45-degree field of view
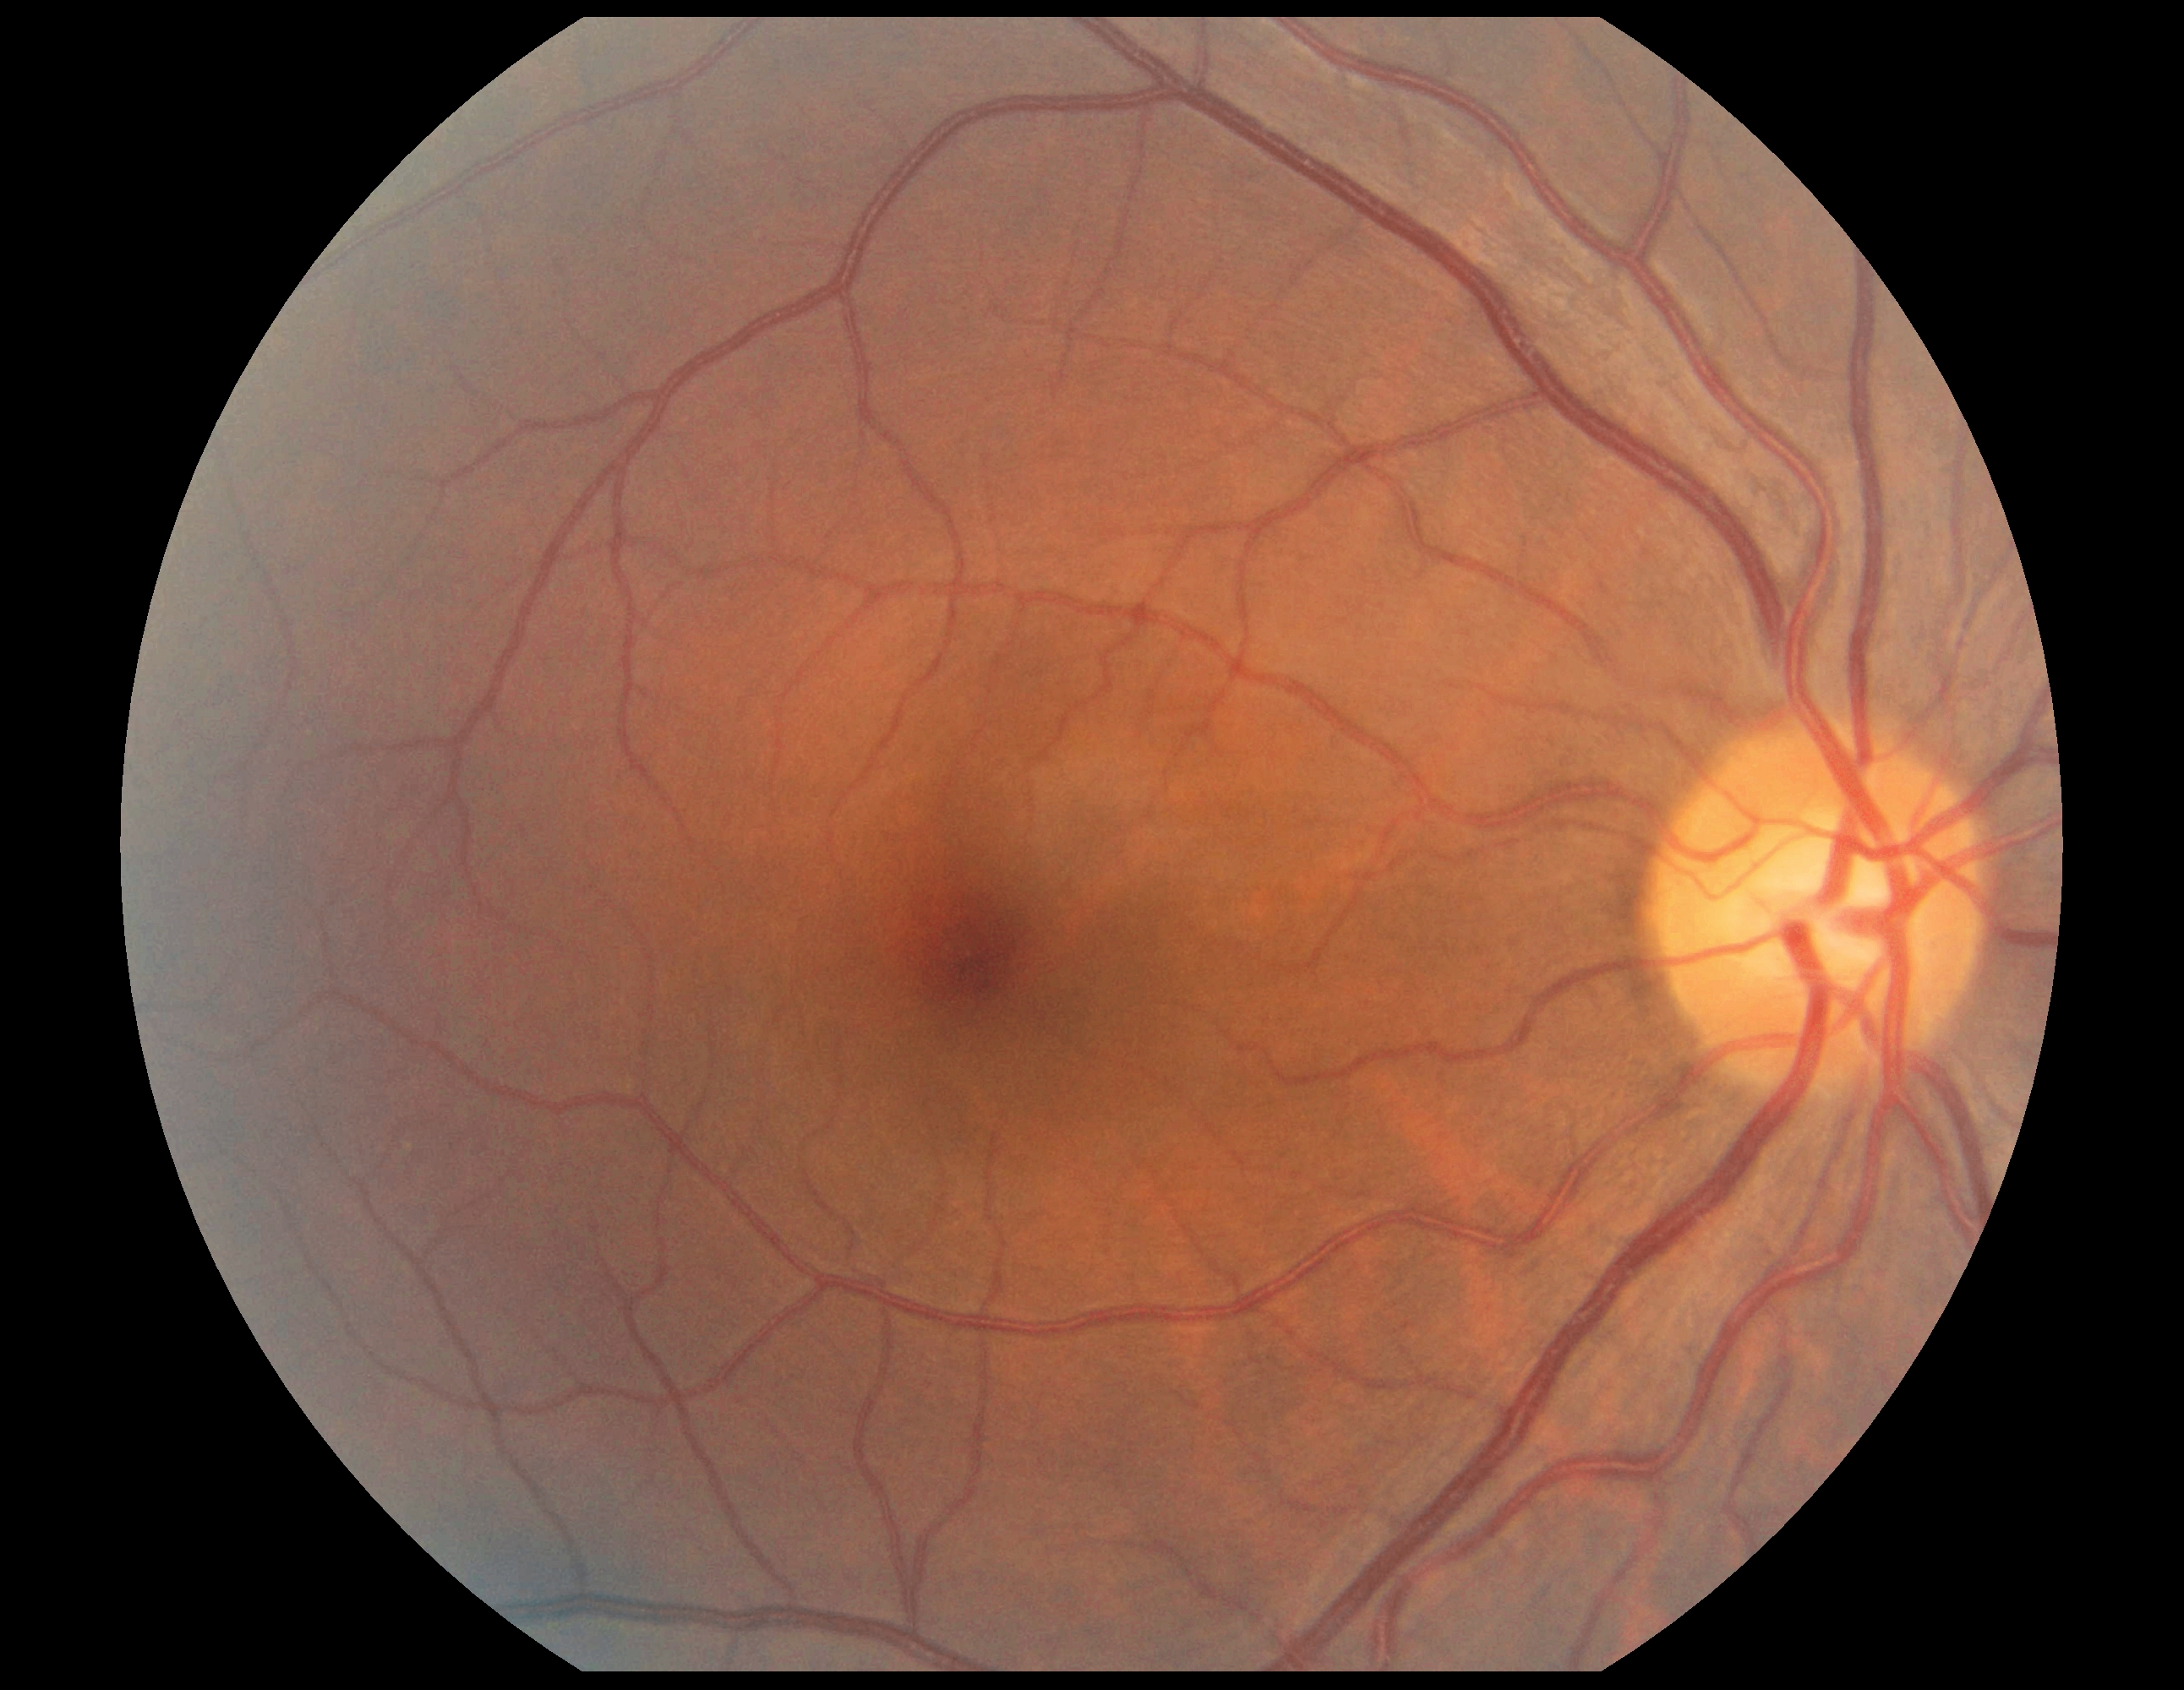 Diabetic retinopathy (DR): grade 0.
No diabetic retinal disease findings.